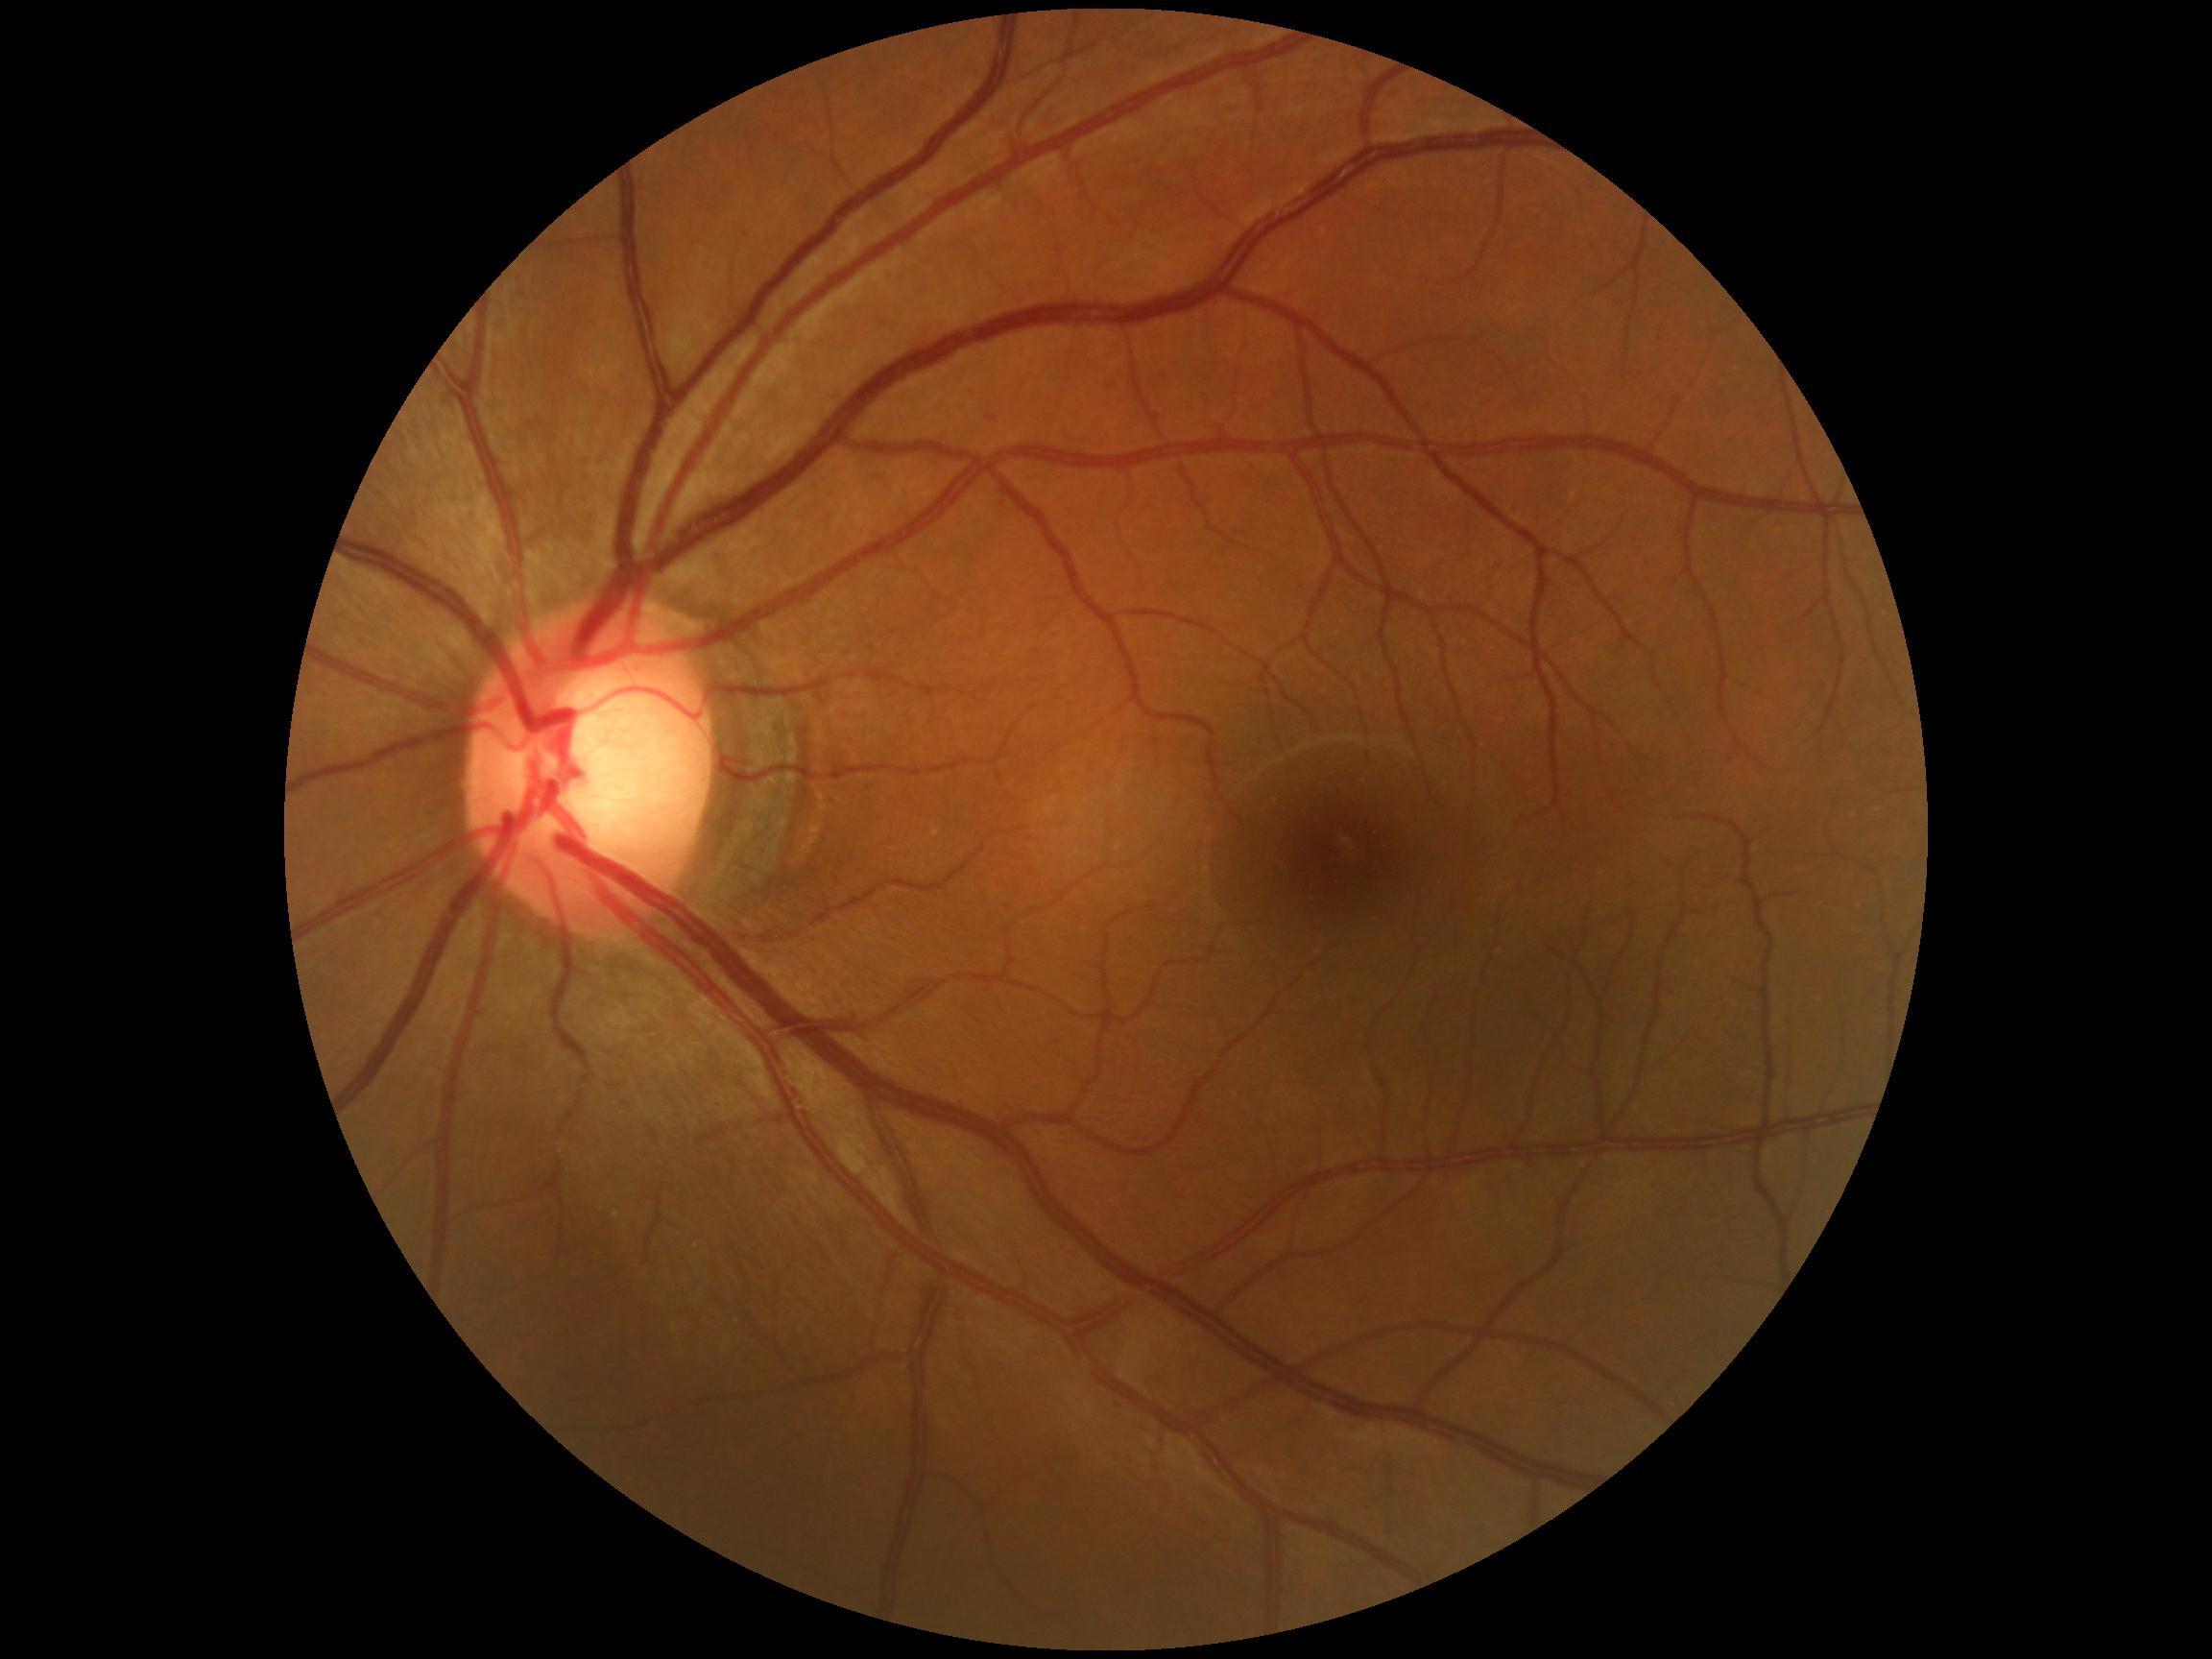 diabetic retinopathy severity: grade 0 (no apparent retinopathy); DR impression: no apparent DR.